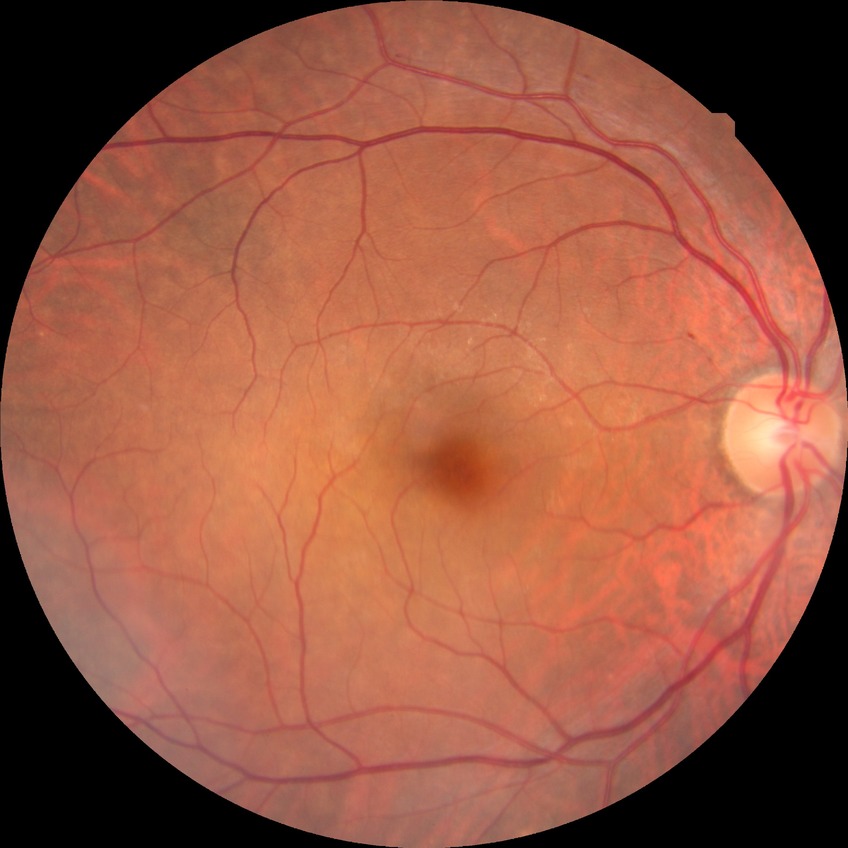
Retinopathy stage: no diabetic retinopathy.